Color fundus photograph. 45-degree field of view
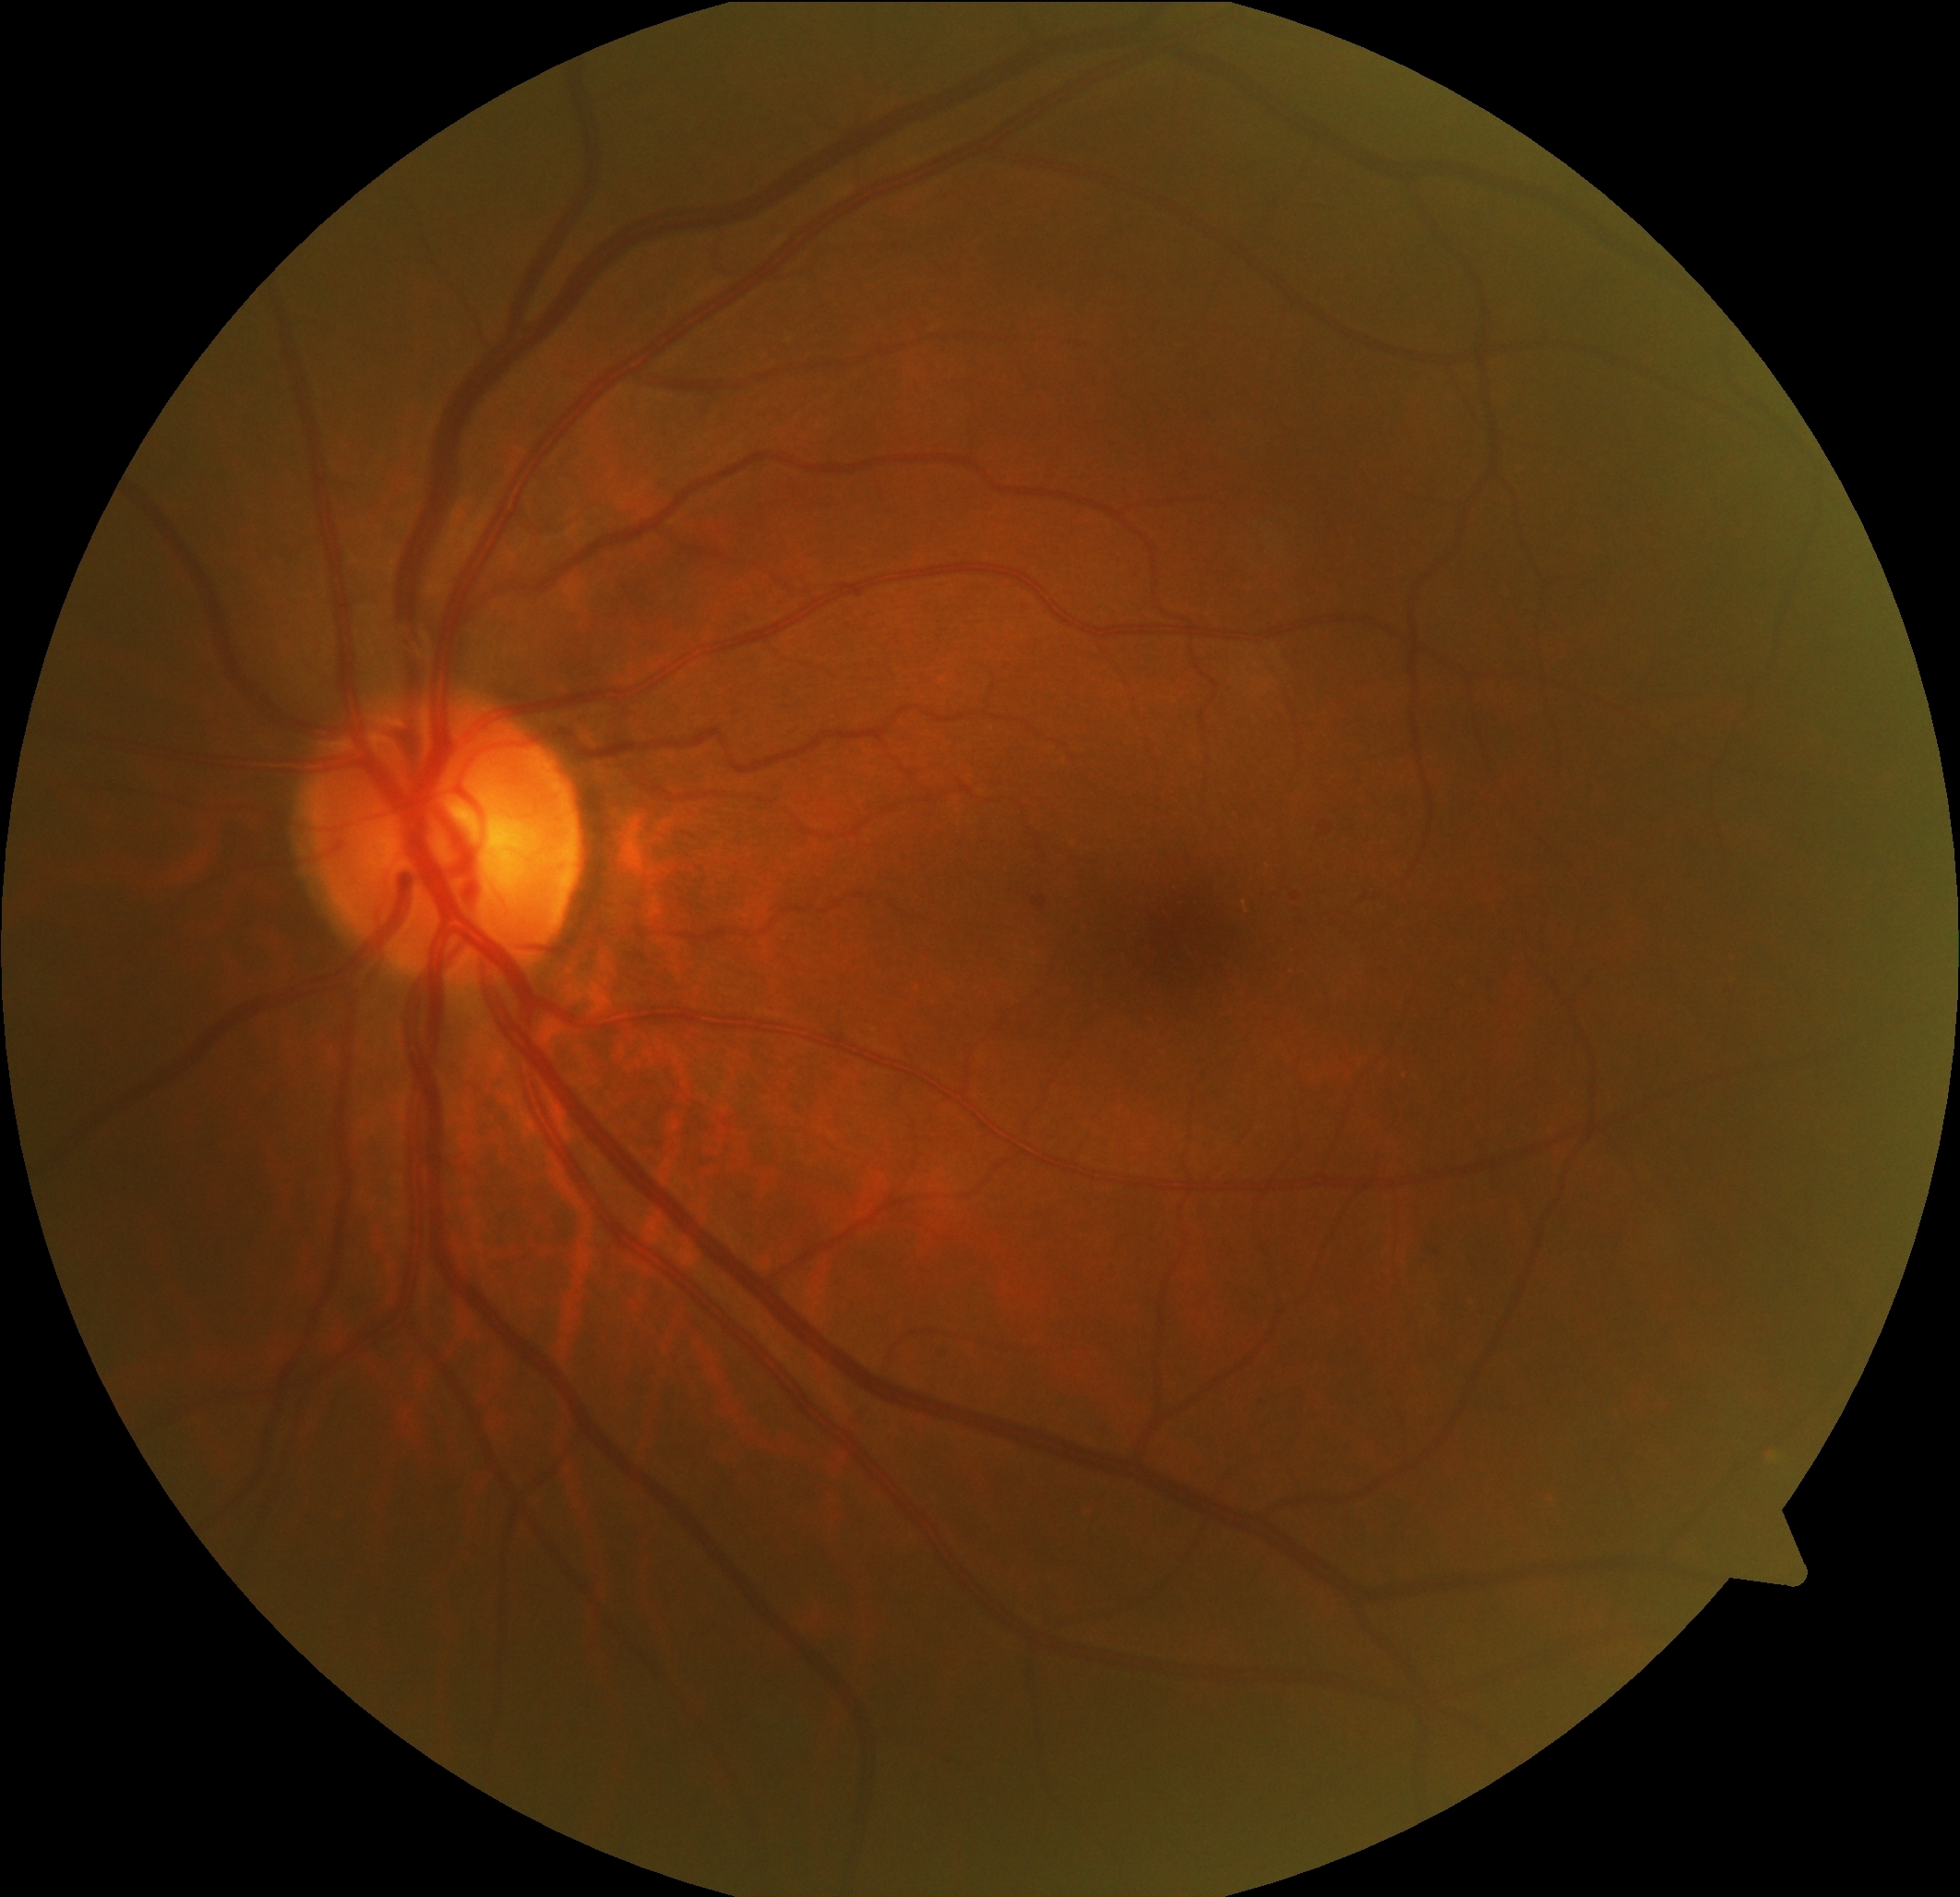 Retinopathy grade is 1 (mild NPDR) — presence of microaneurysms only.